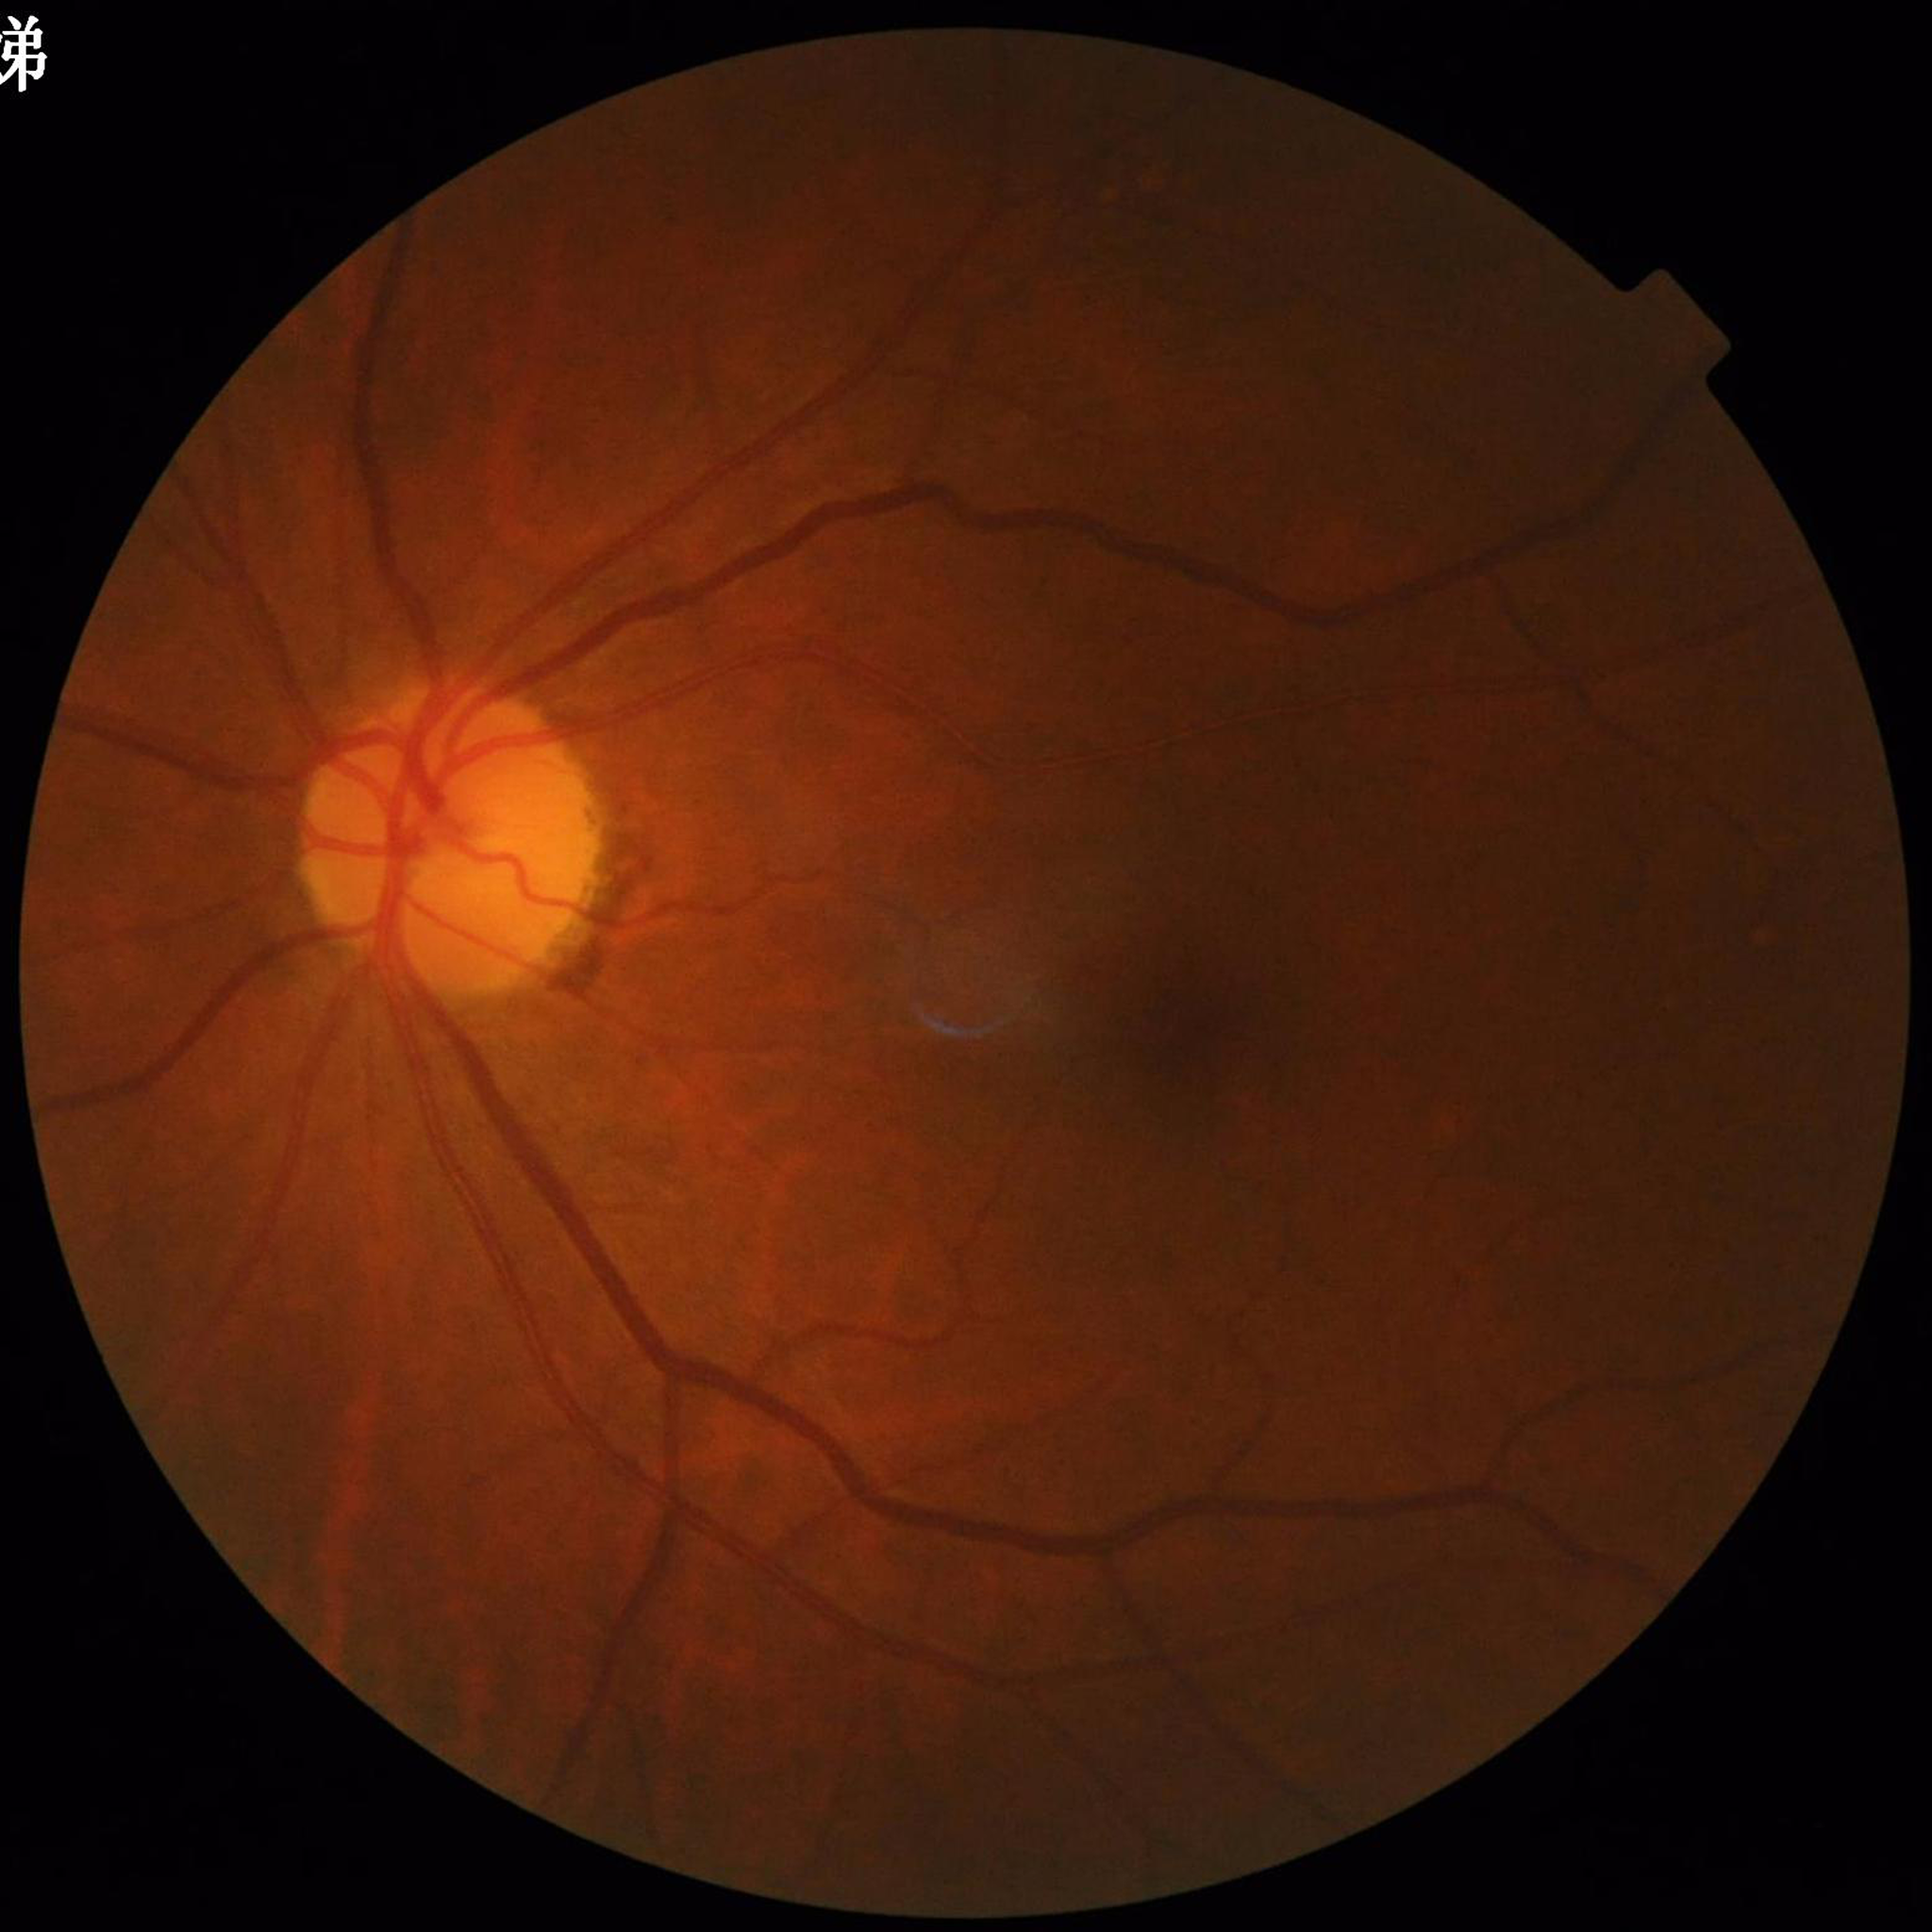 The patient was diagnosed with glaucoma.